Color fundus photograph · 2048 by 1536 pixels:
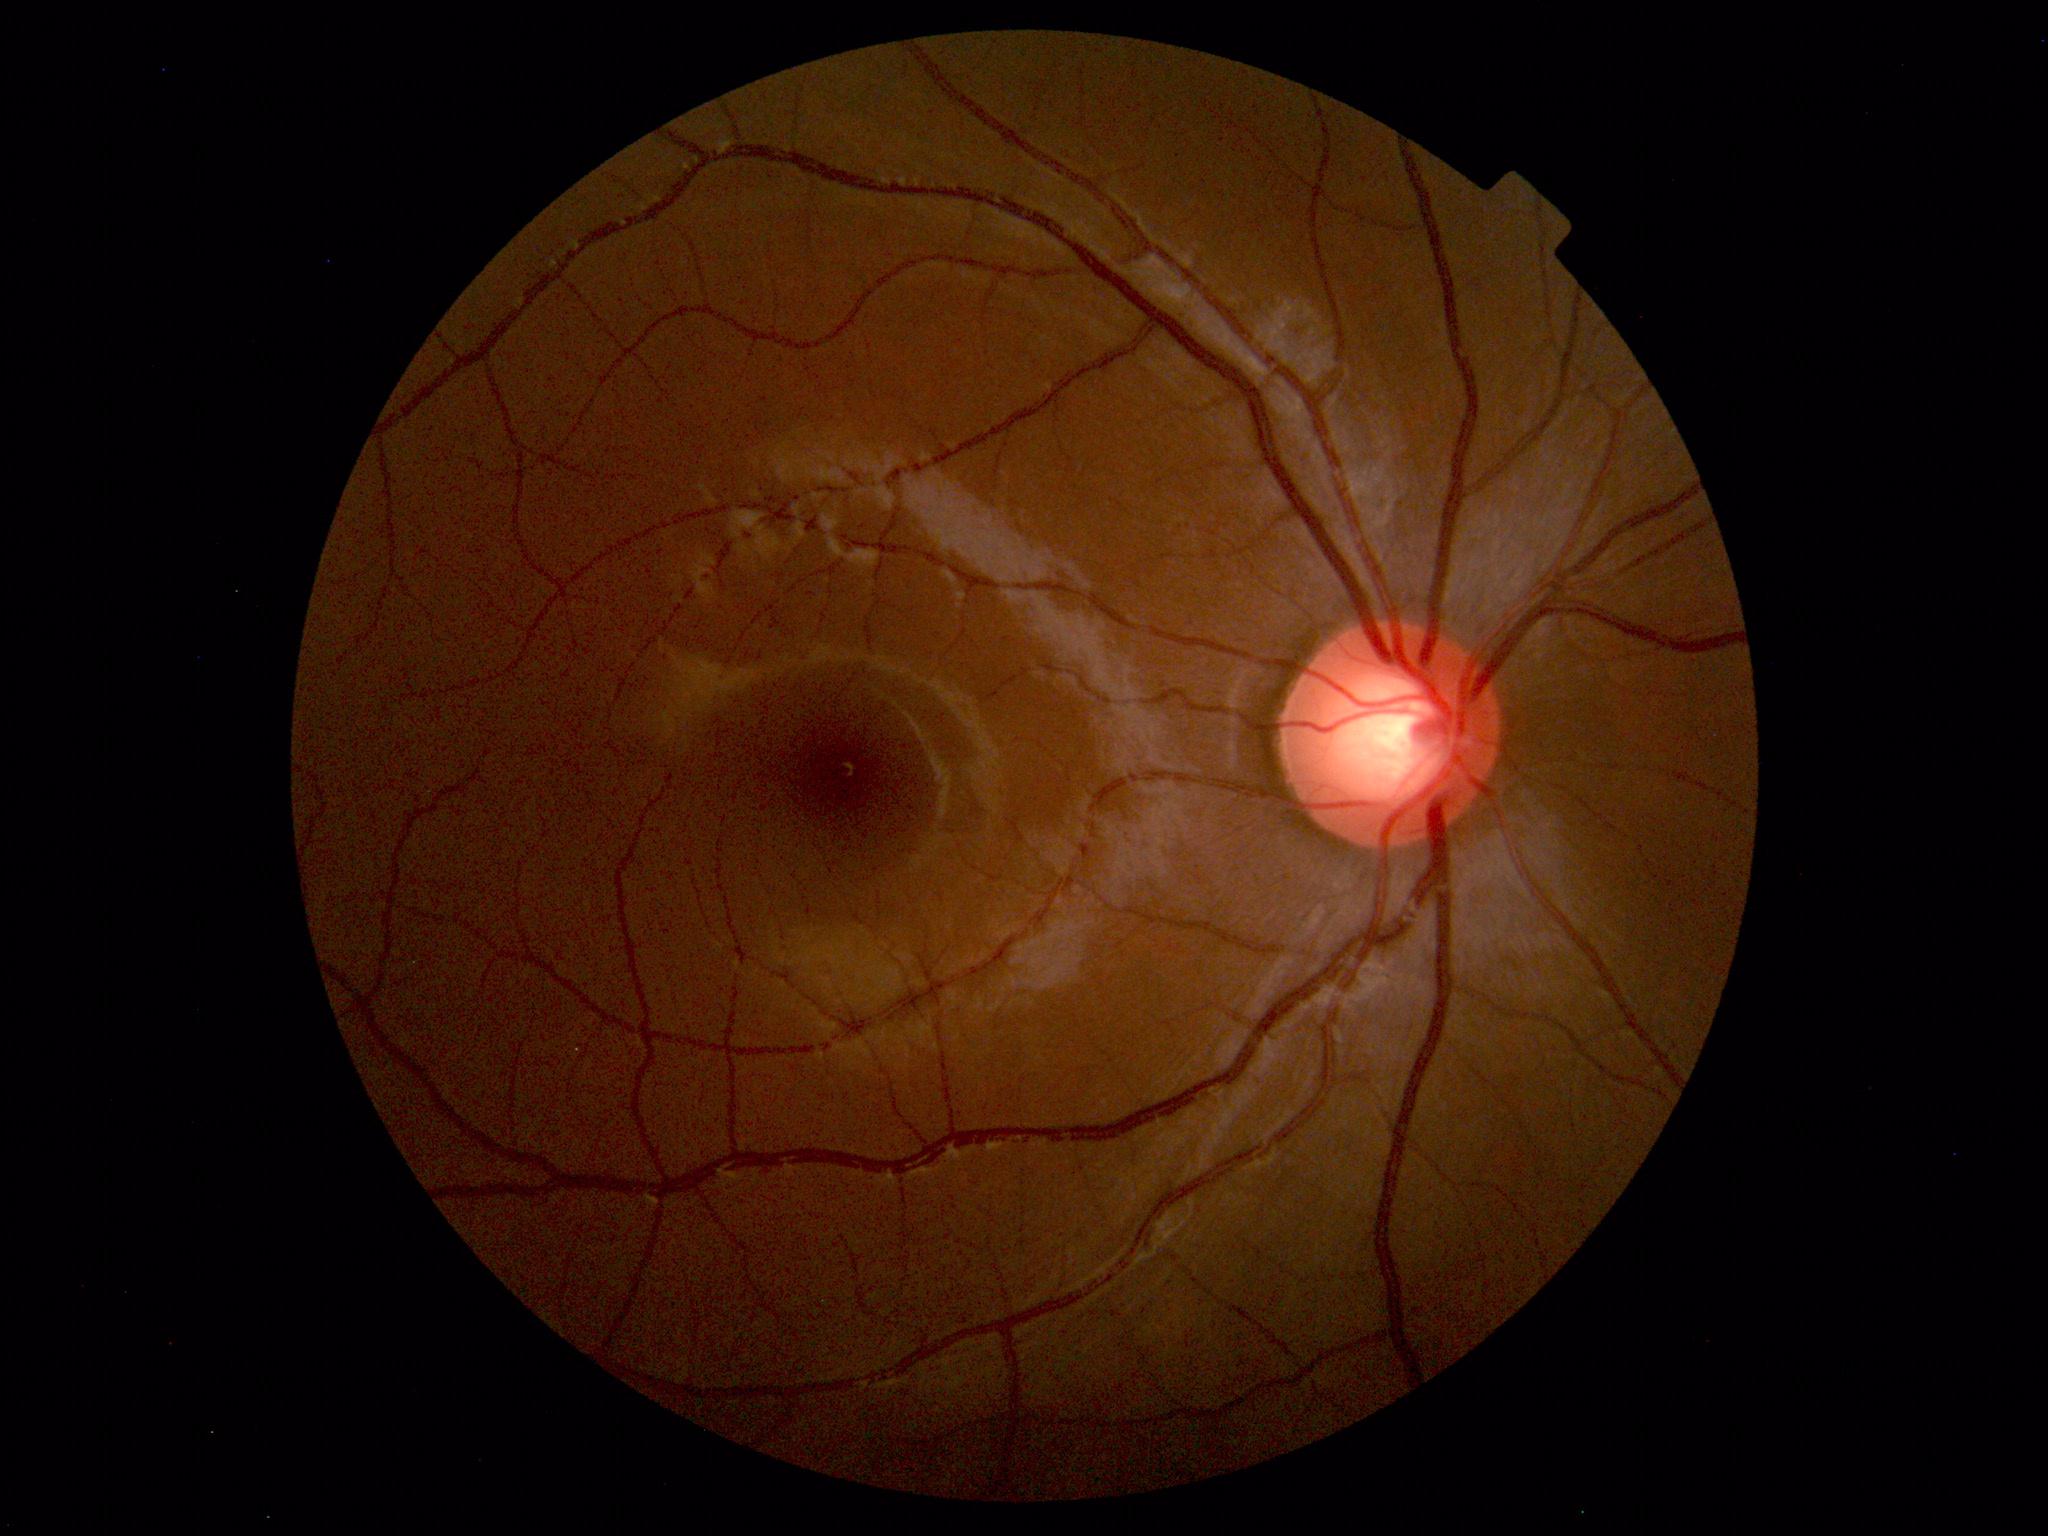

Findings: none. Normal fundus.